45° field of view: 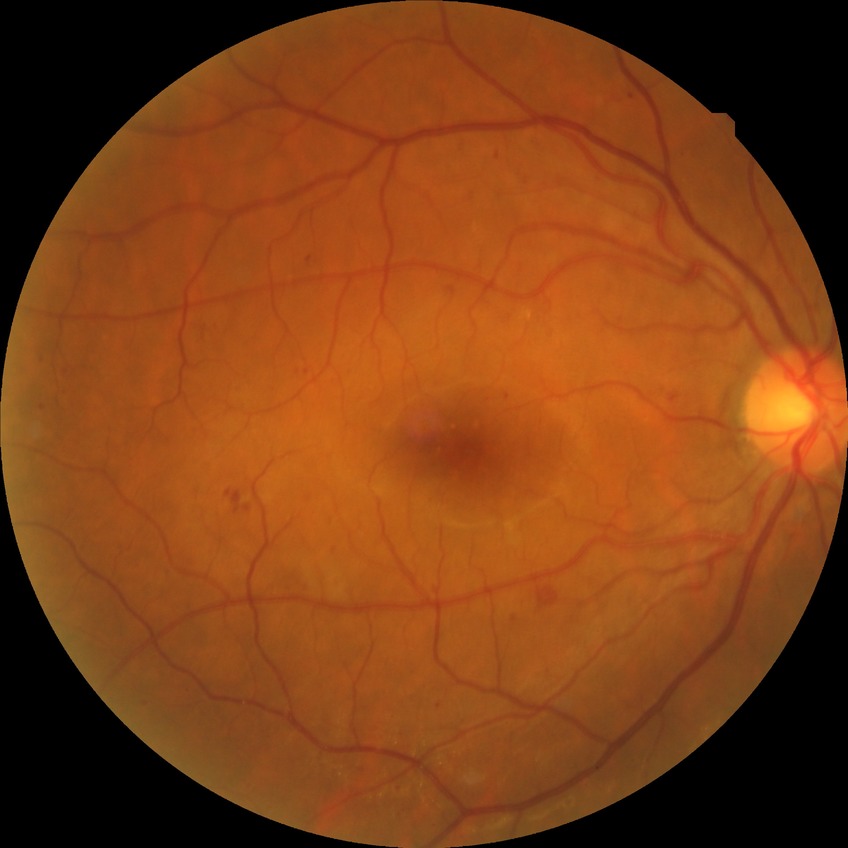

Diabetic retinopathy severity: pre-proliferative diabetic retinopathy.